1440 by 1080 pixels · wide-field fundus photograph from neonatal ROP screening: 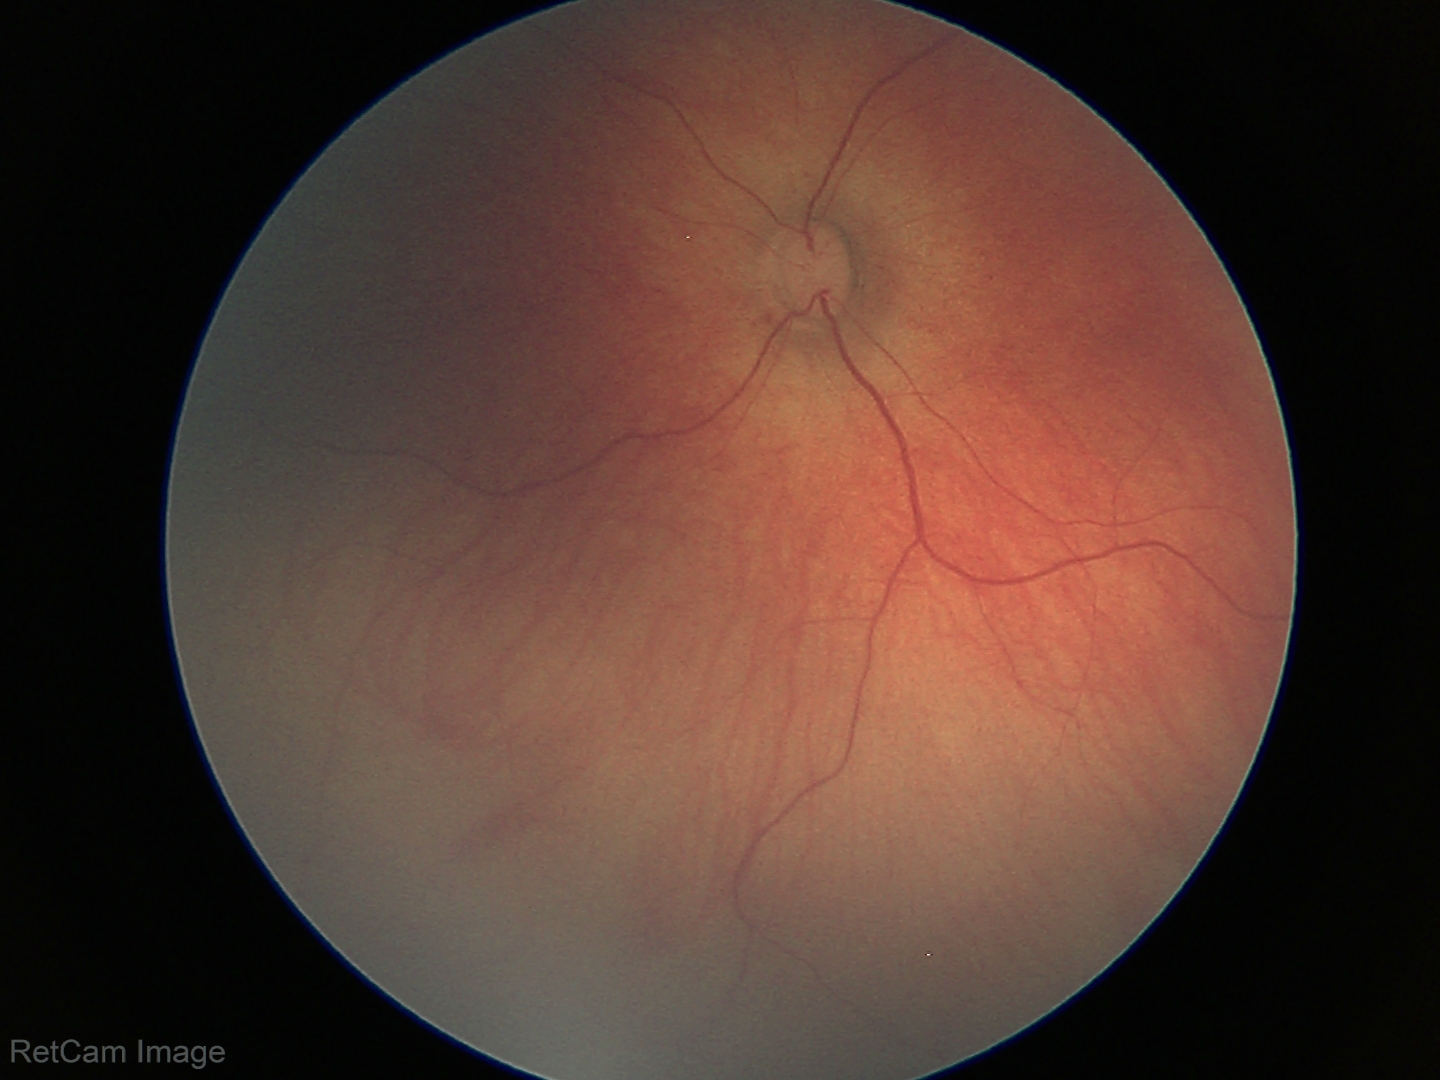 Physiological retinal appearance for postconceptual age.